Central posterior field · dilated-pupil acquisition: 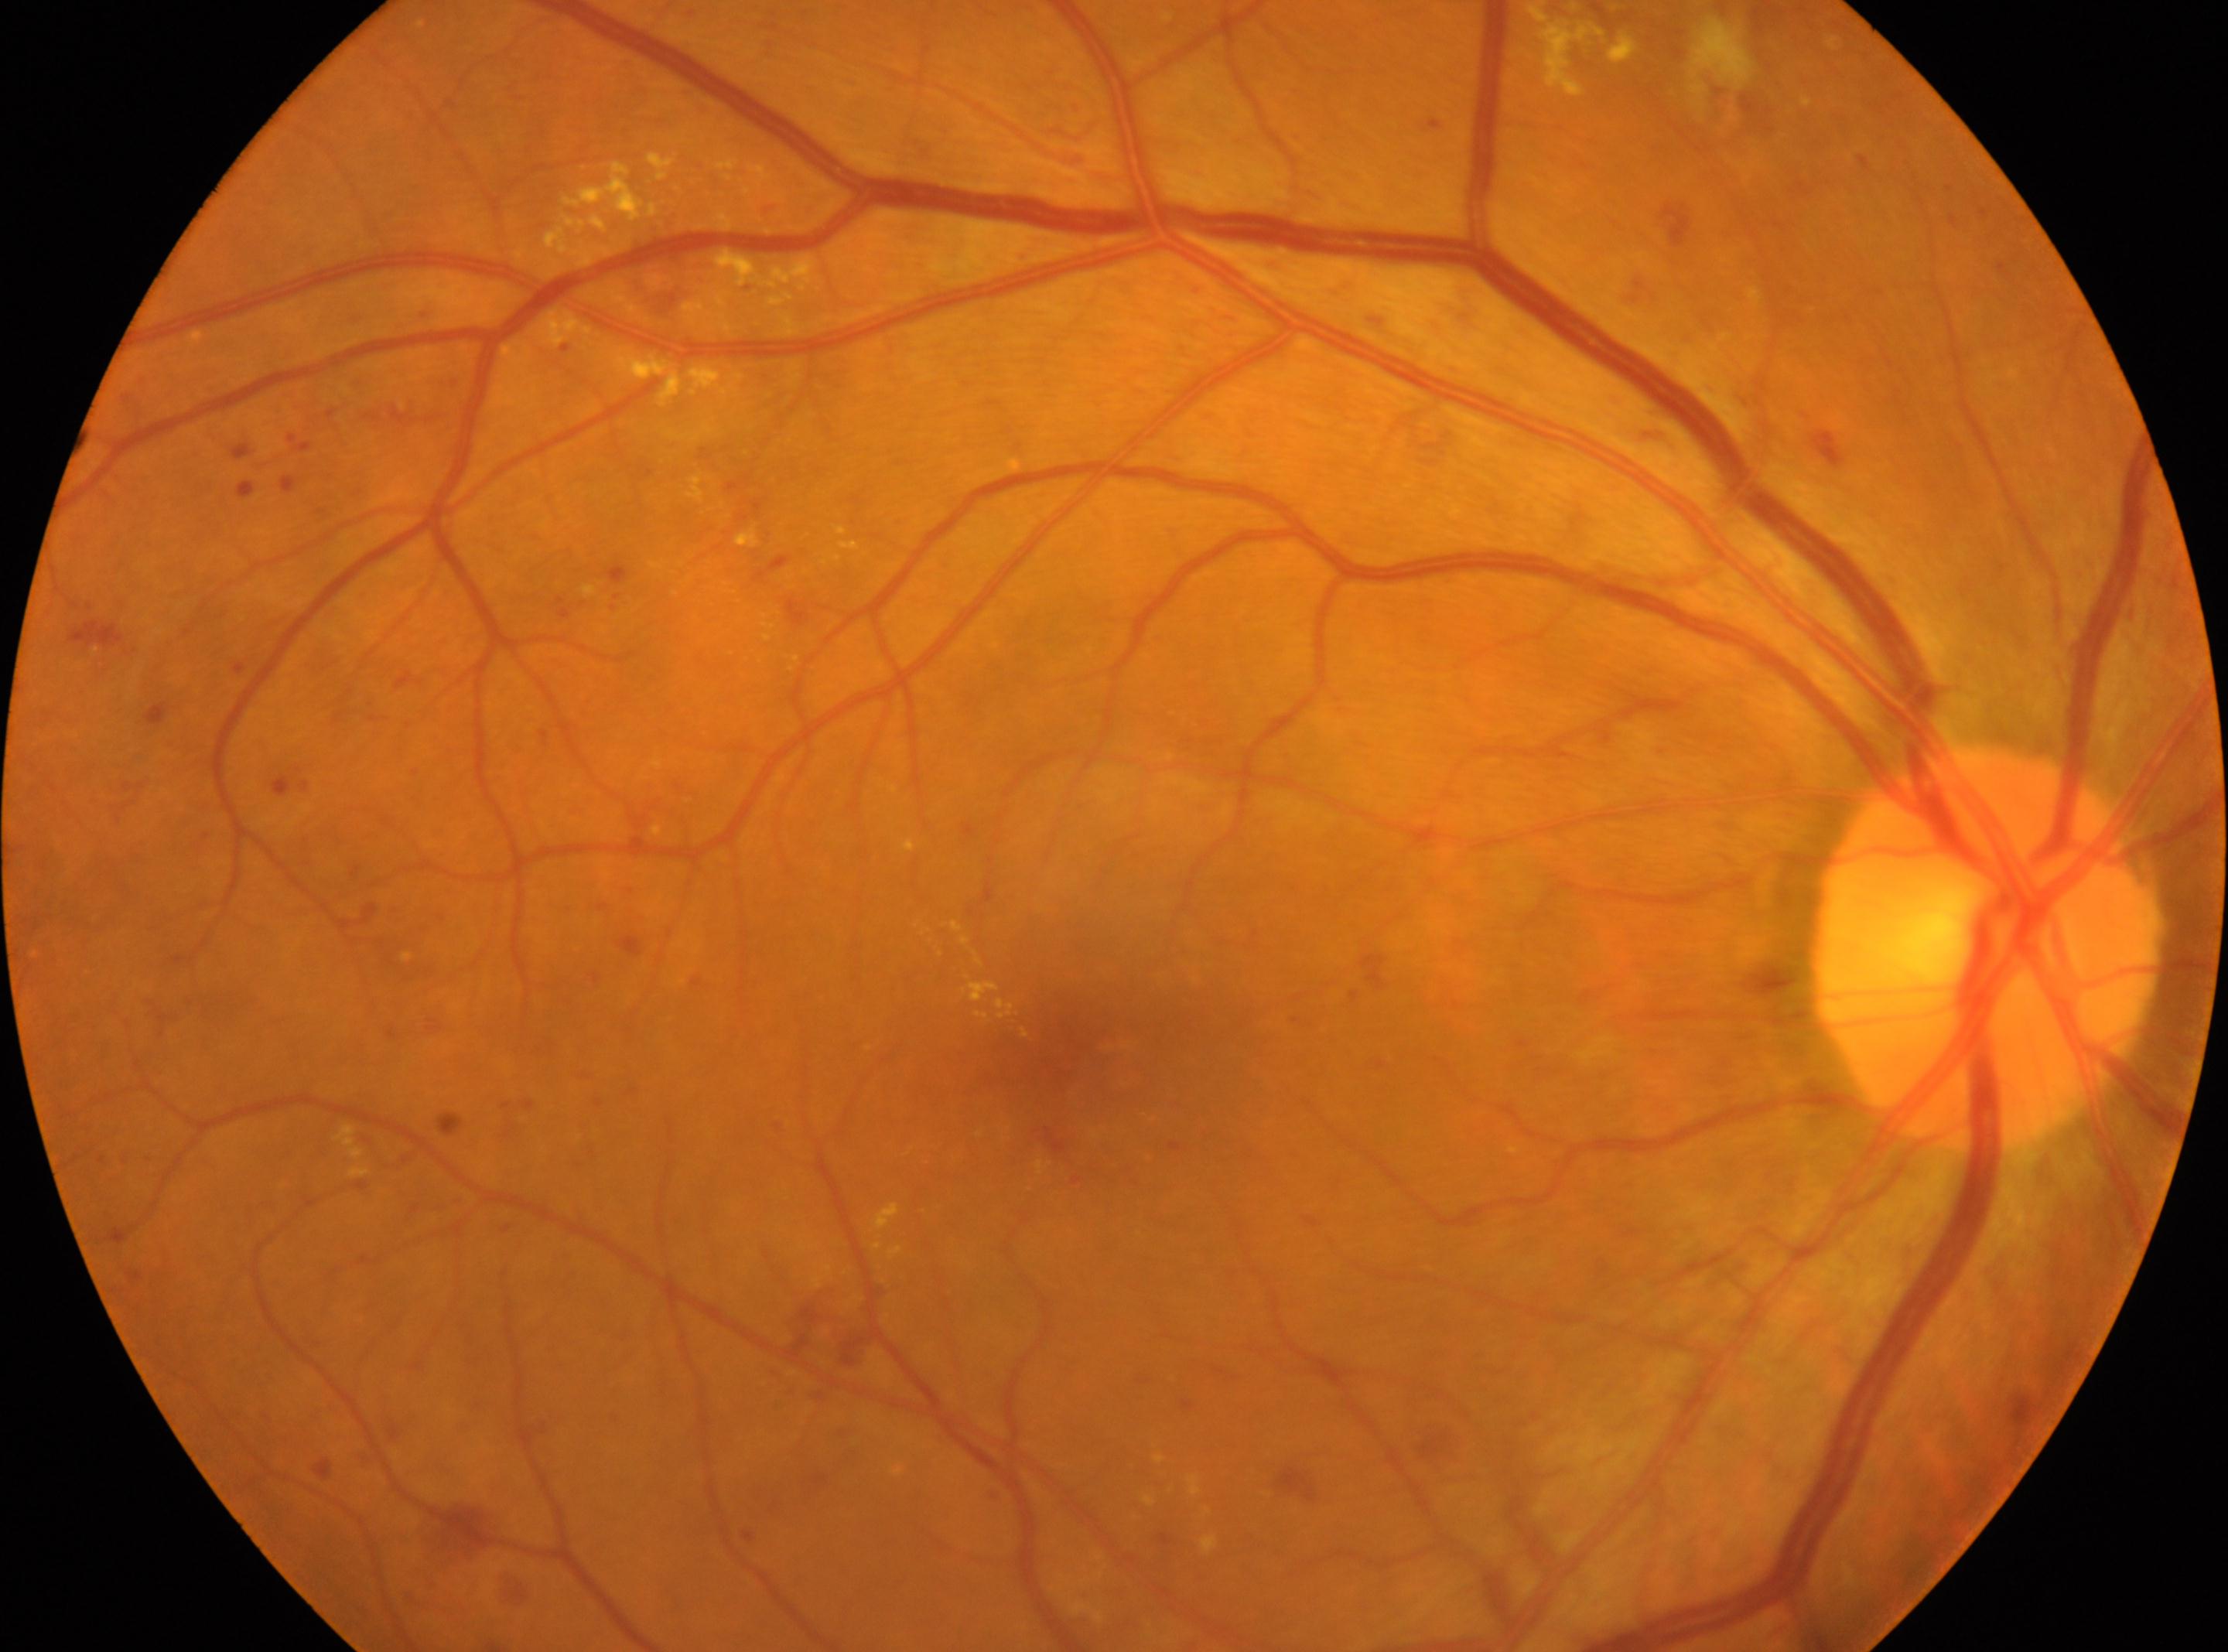   optic_disc: 1987px, 950px
  fovea: 1055px, 1058px
  eye: oculus dexter
  dr_grade: 3 (severe NPDR)